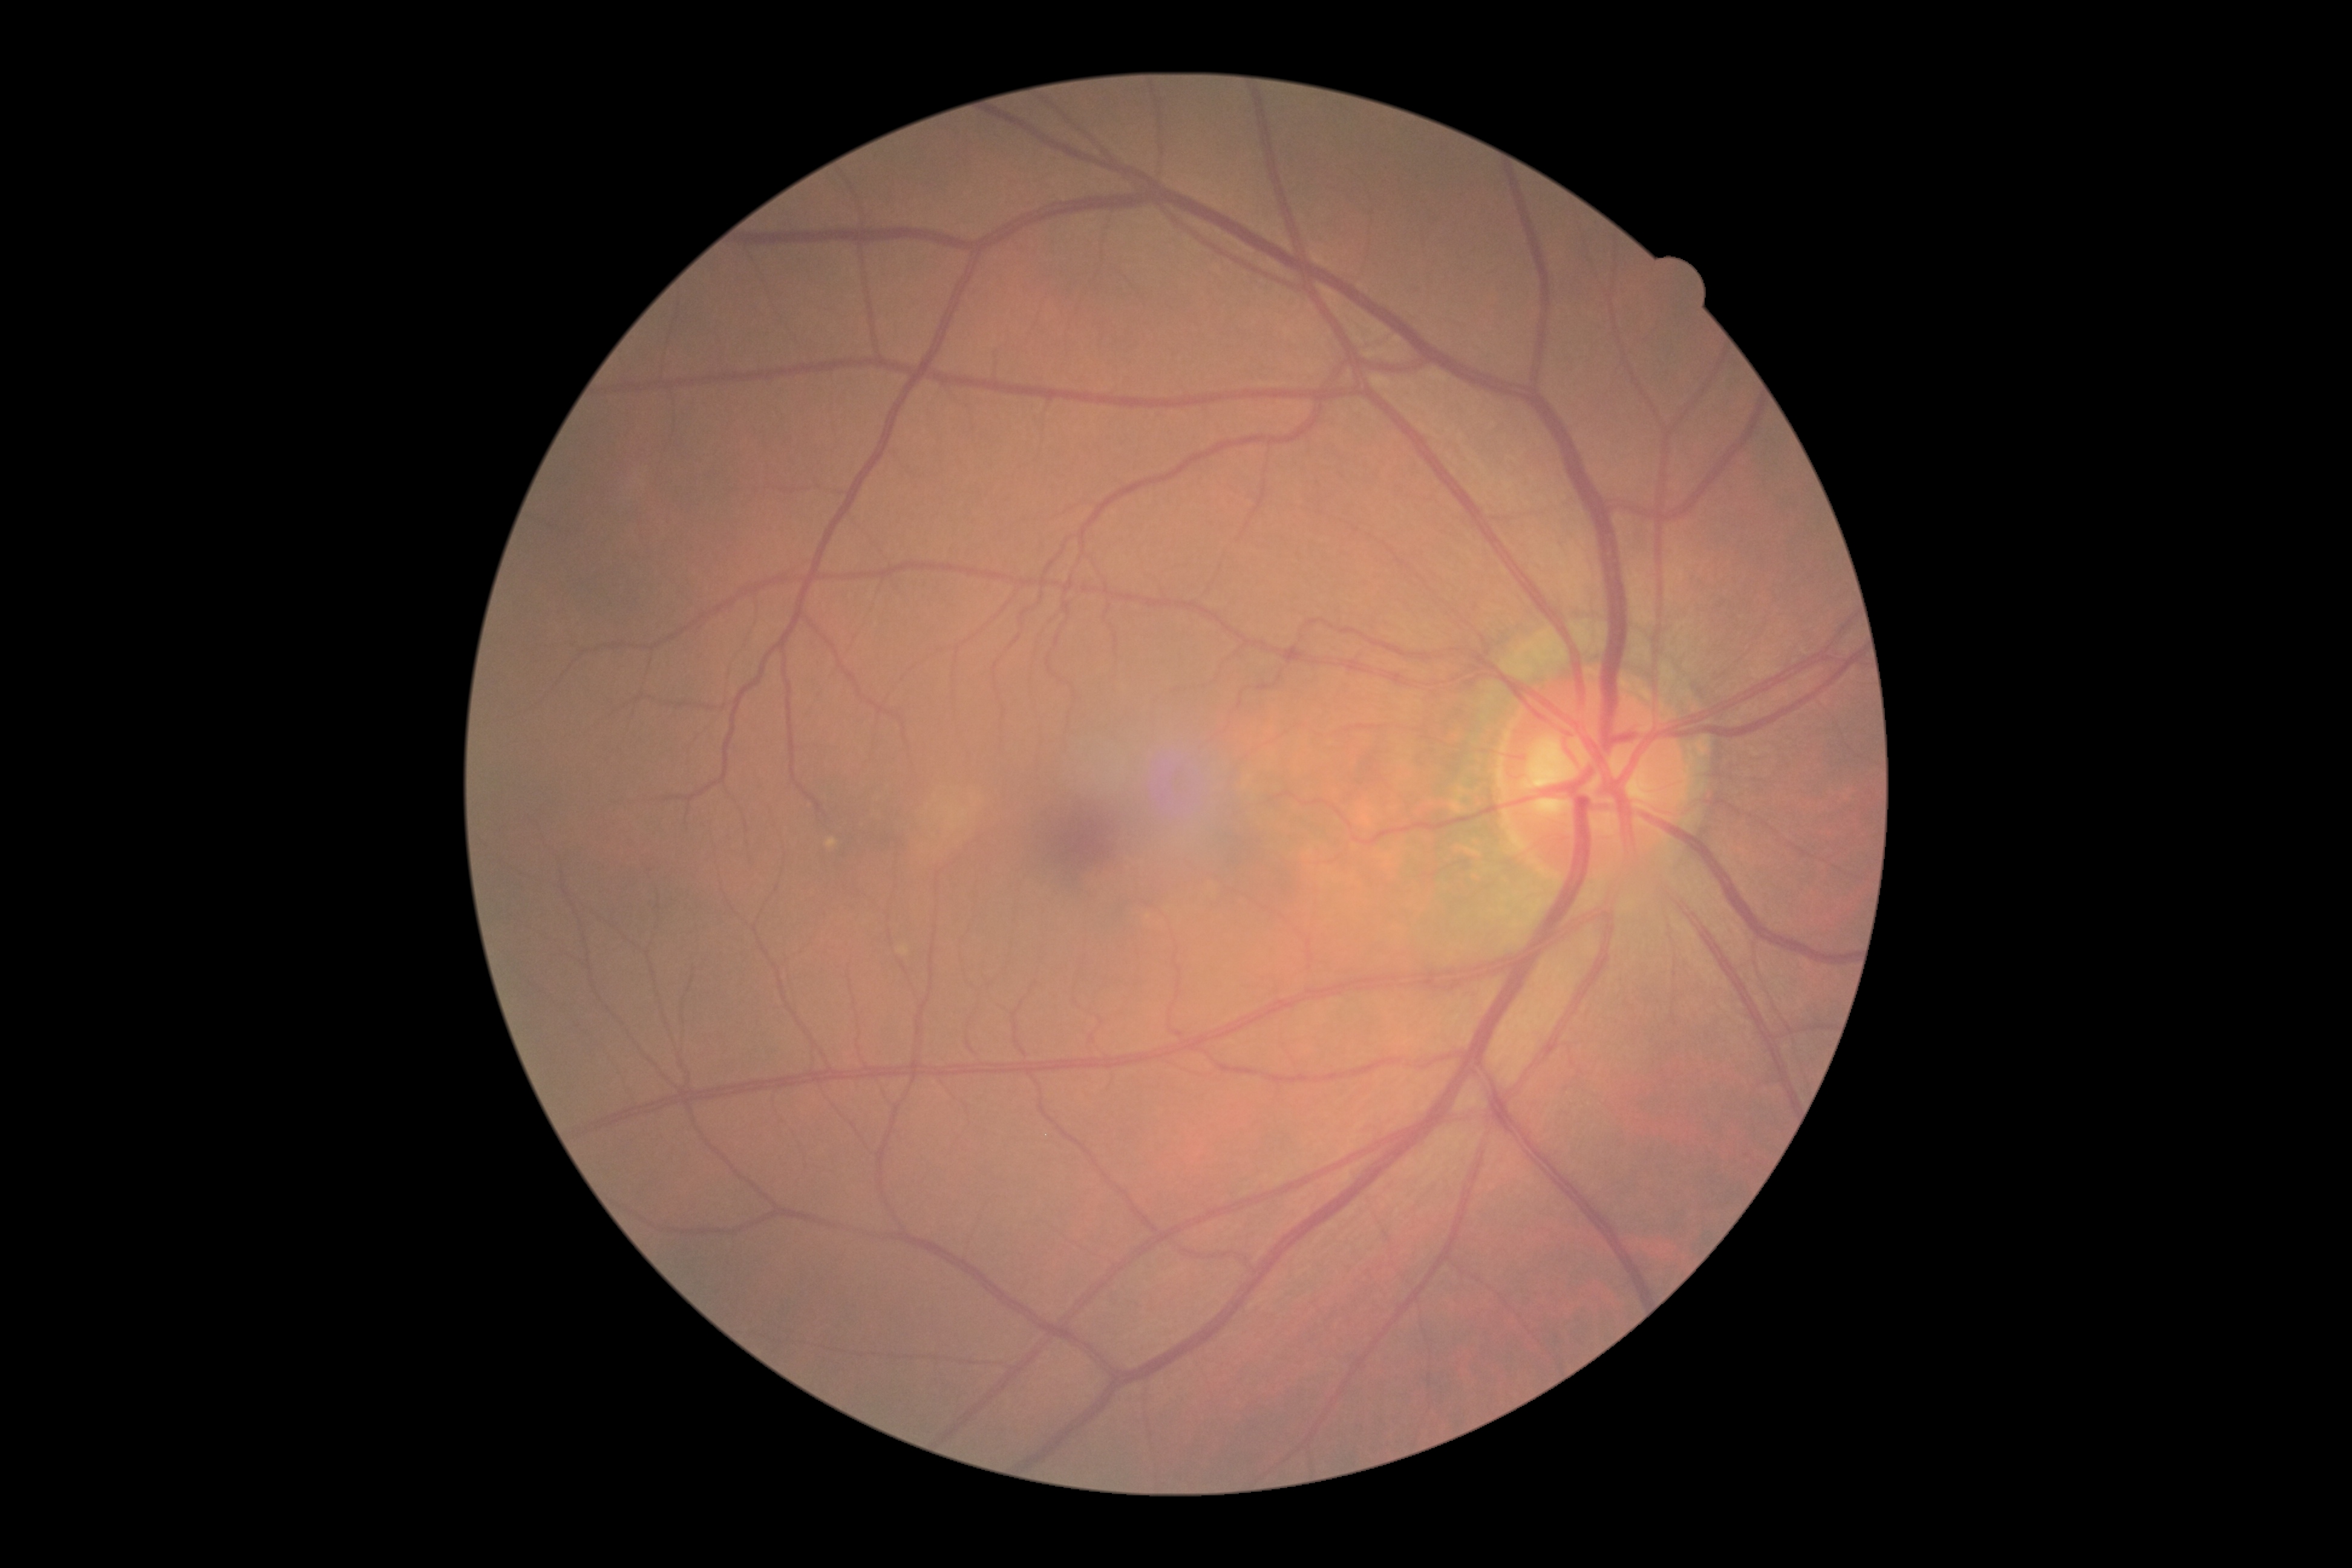 Diabetic retinopathy (DR): 0.